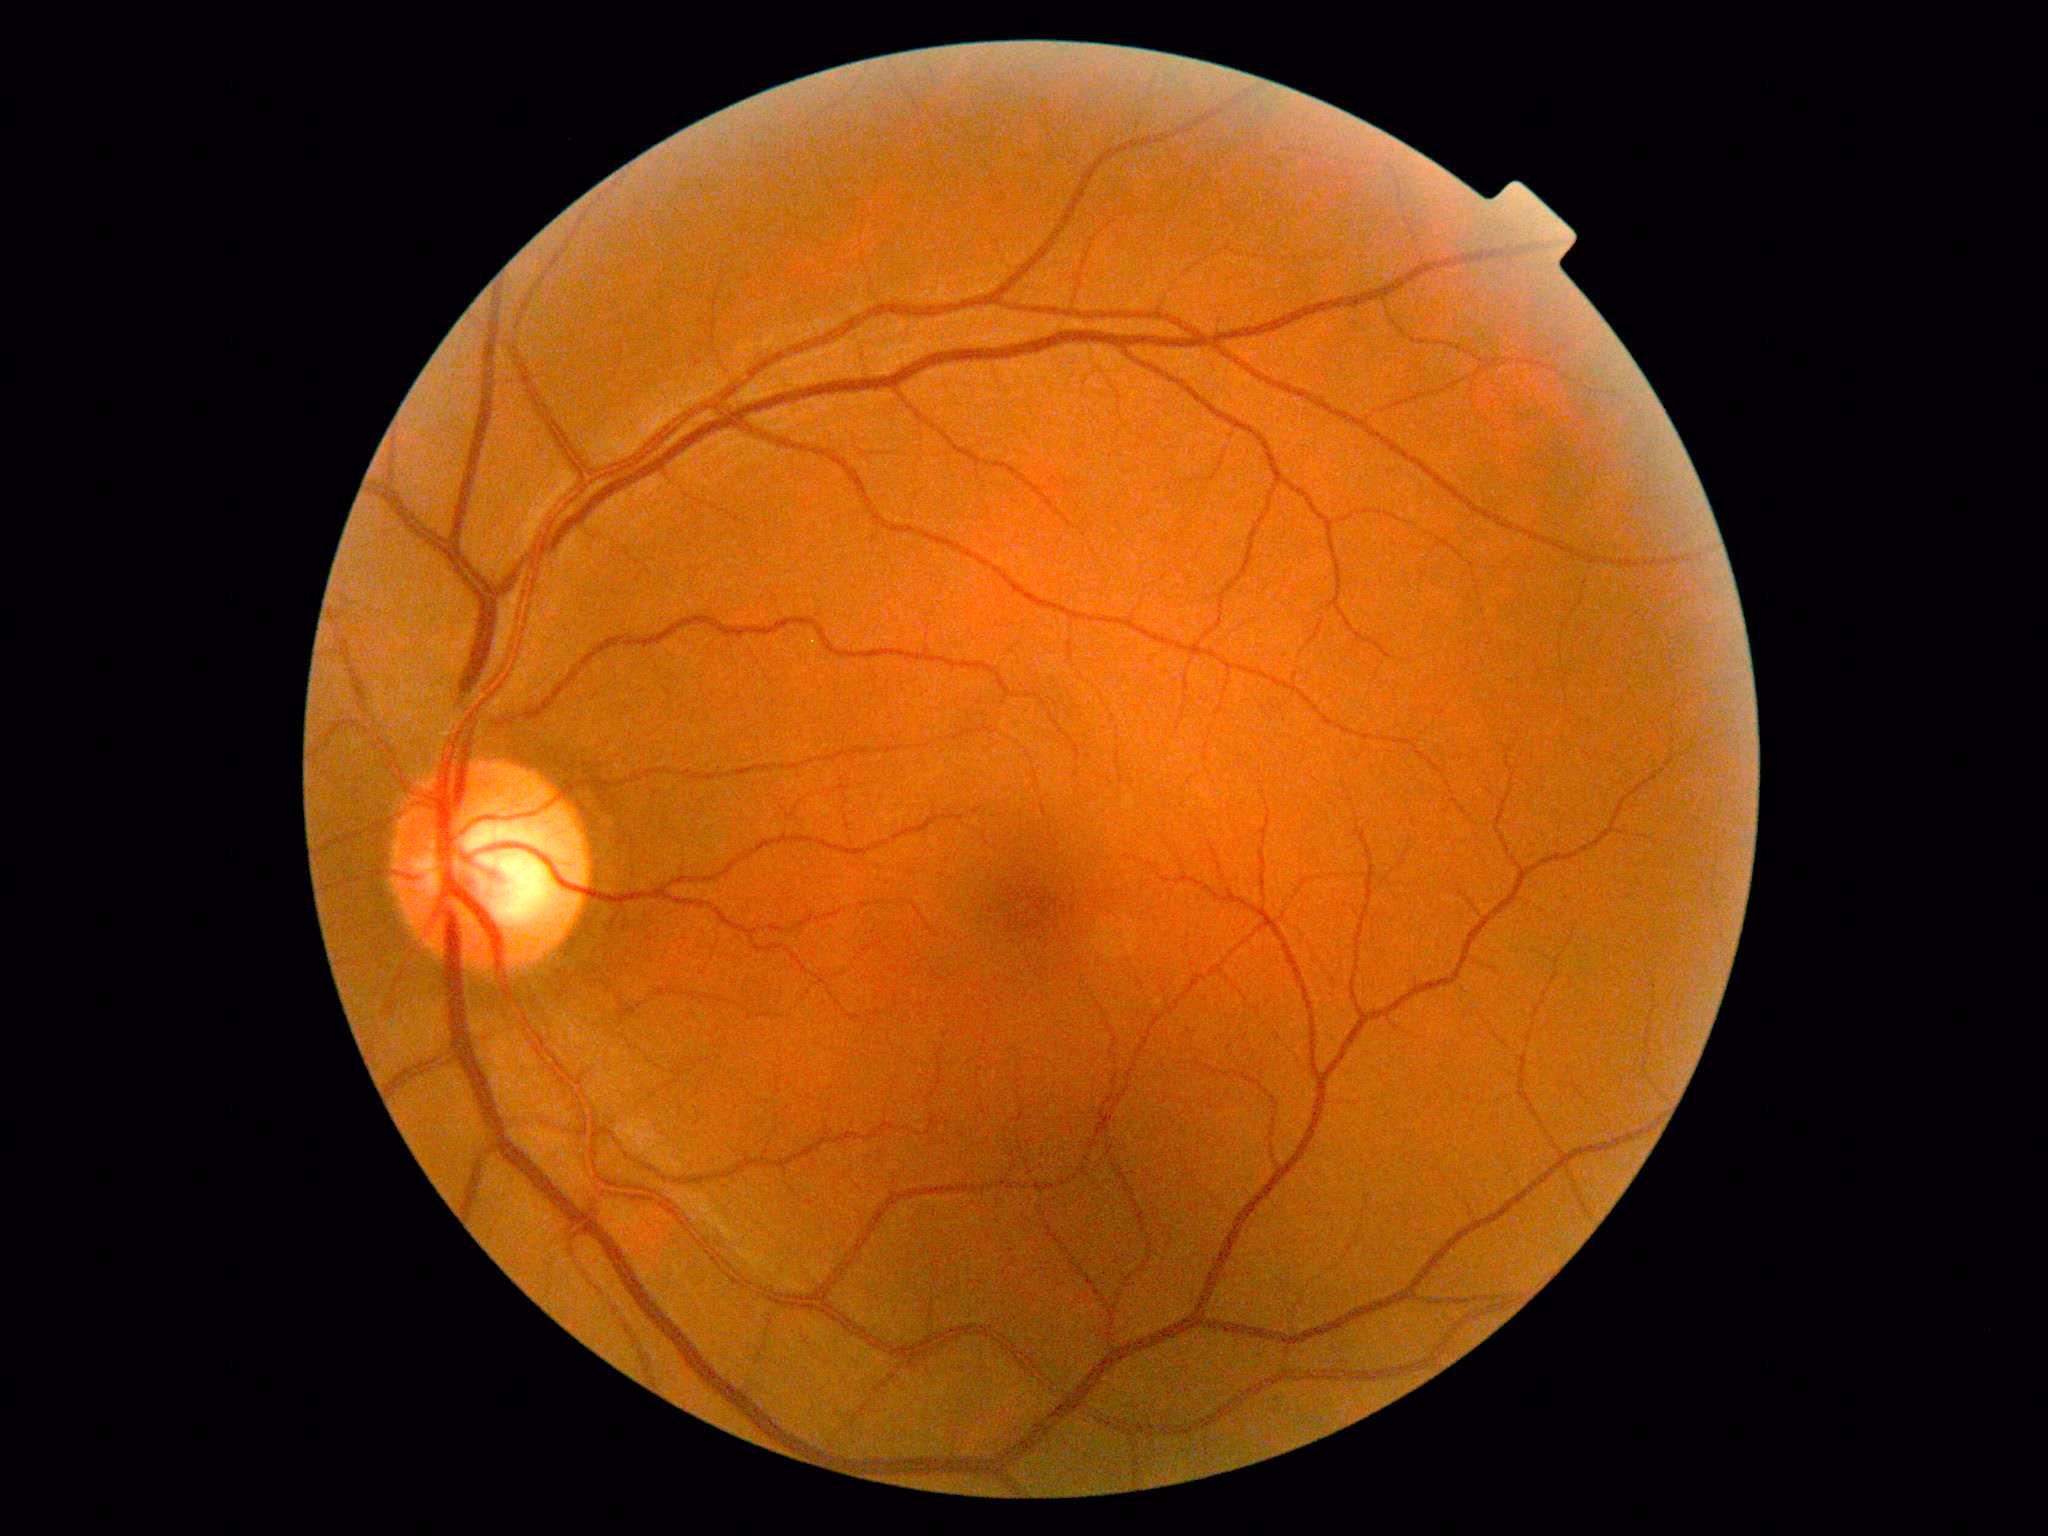
No apparent diabetic retinopathy. Diabetic retinopathy (DR): grade 0 (no apparent retinopathy).